848x848px. Without pupil dilation. FOV: 45 degrees — 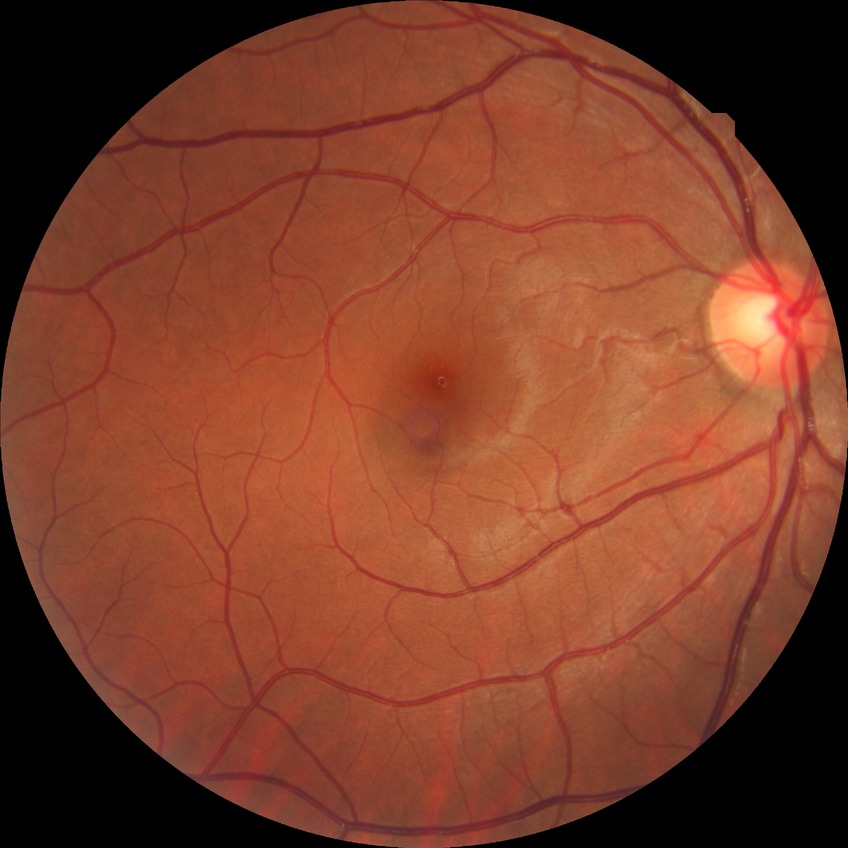

retinopathy stage = no diabetic retinopathy.